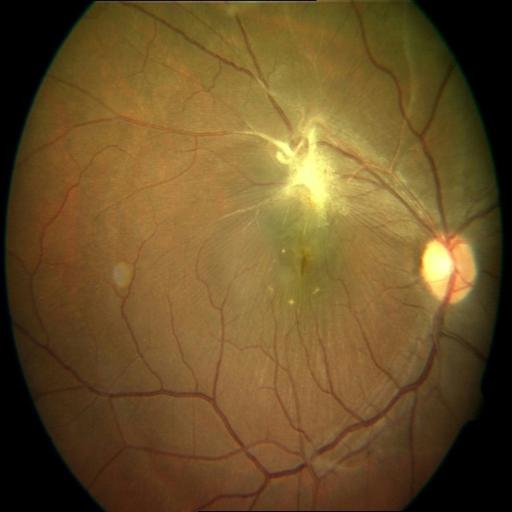
Findings: retinal traction.